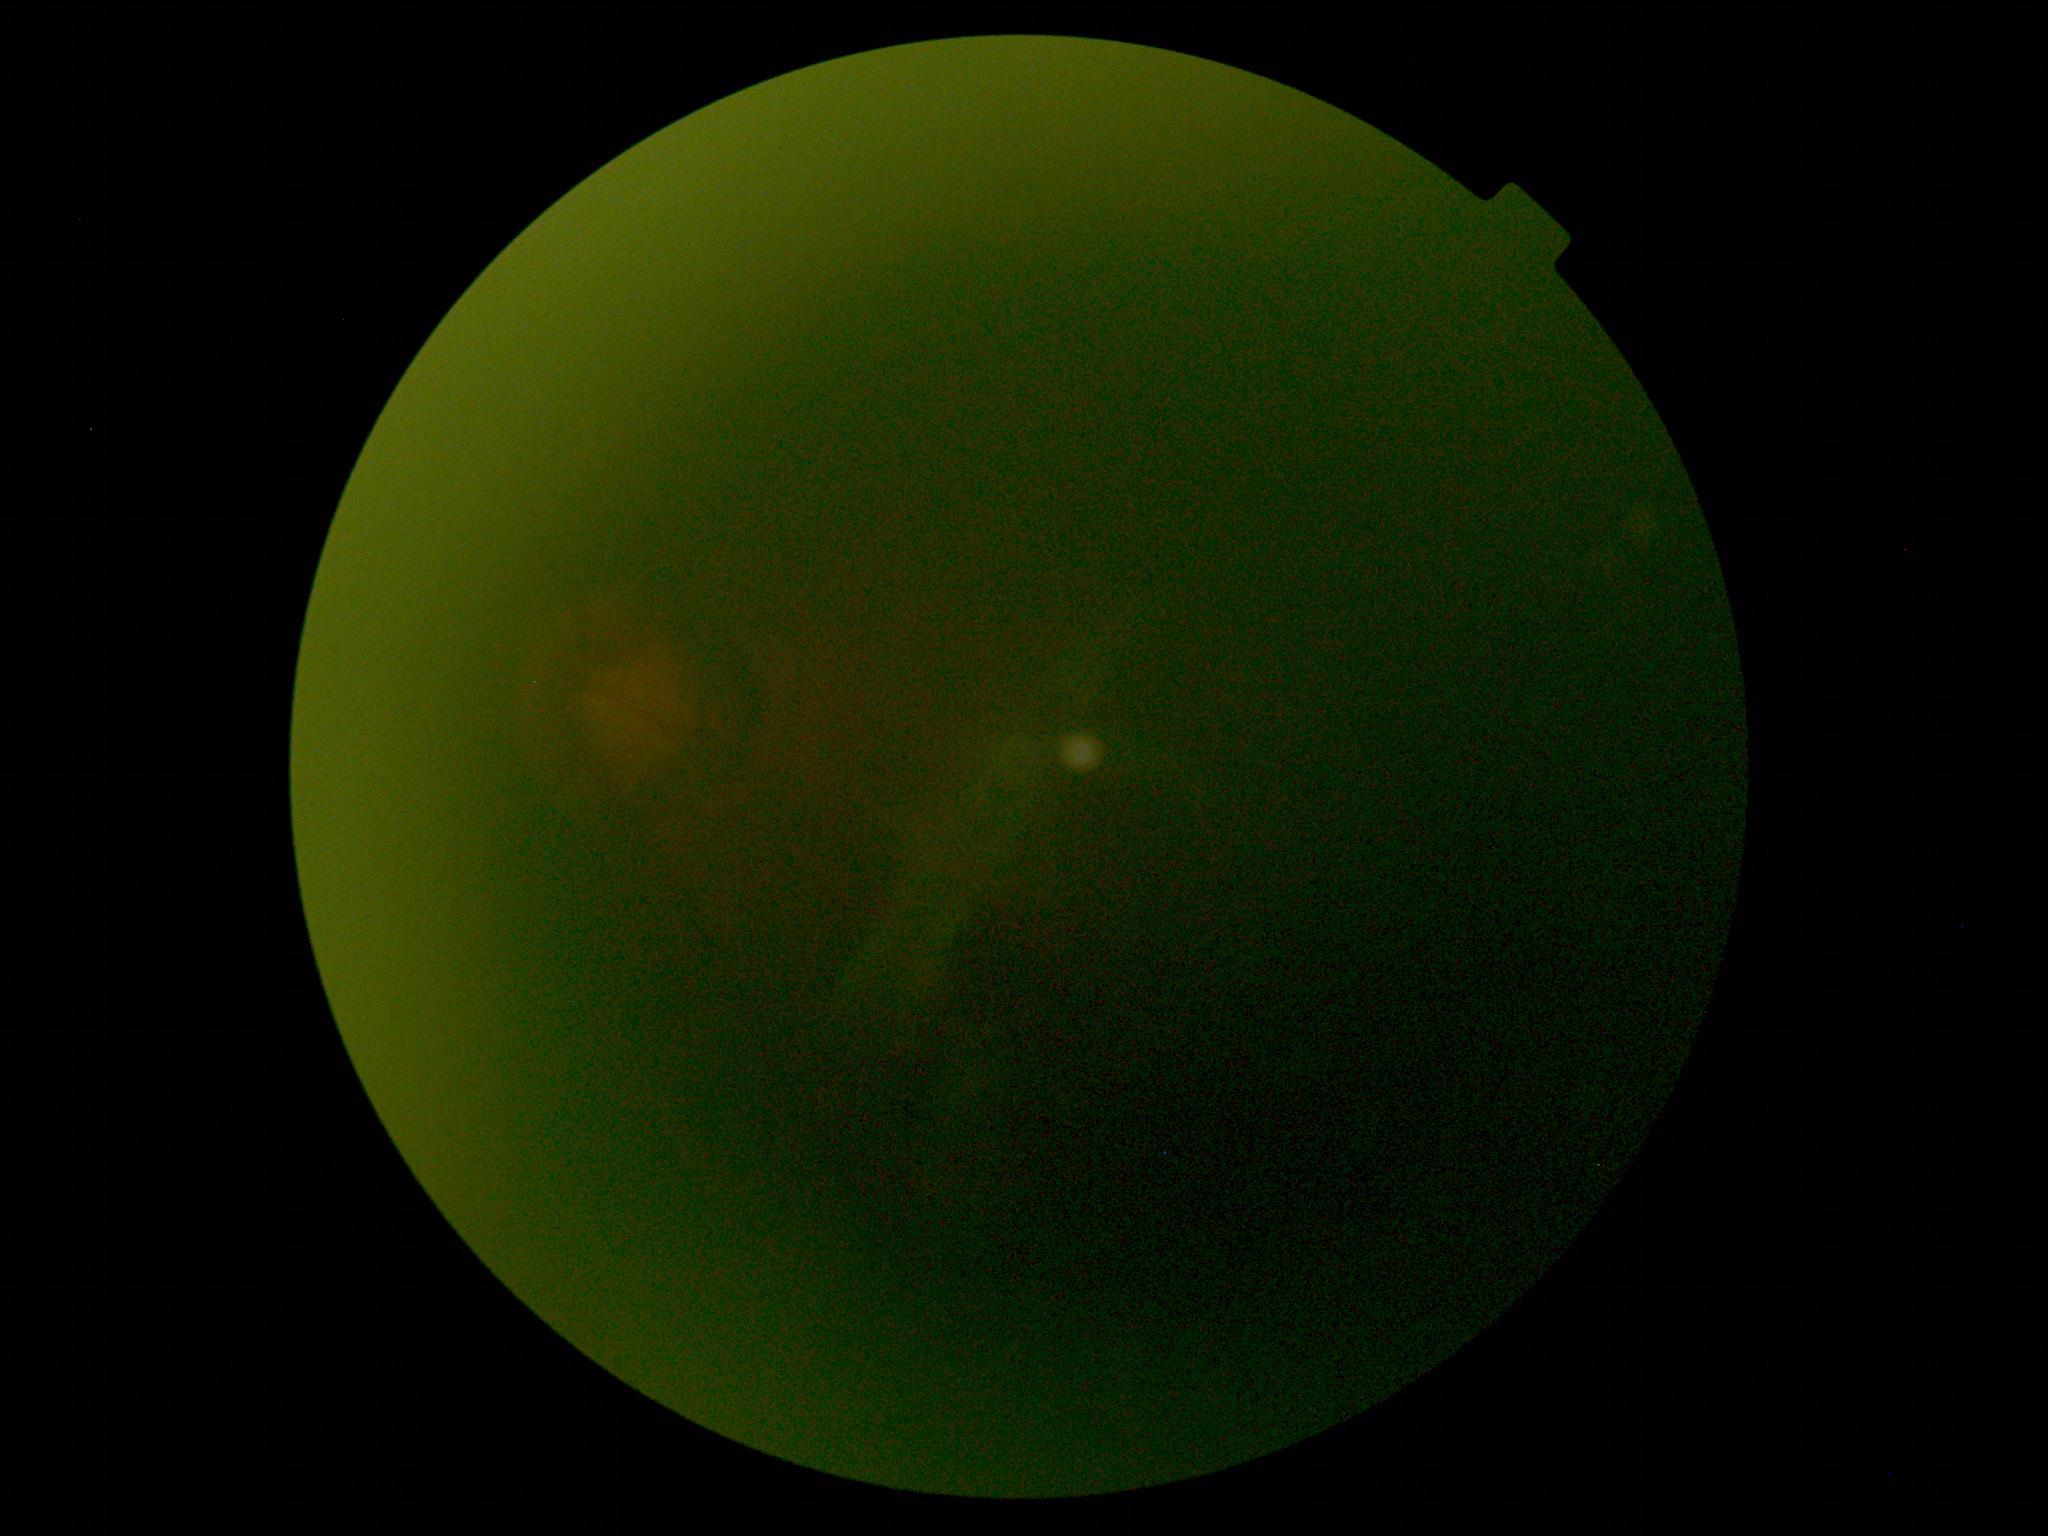

Image quality is insufficient for diabetic retinopathy assessment.
DR severity is ungradable due to poor image quality.